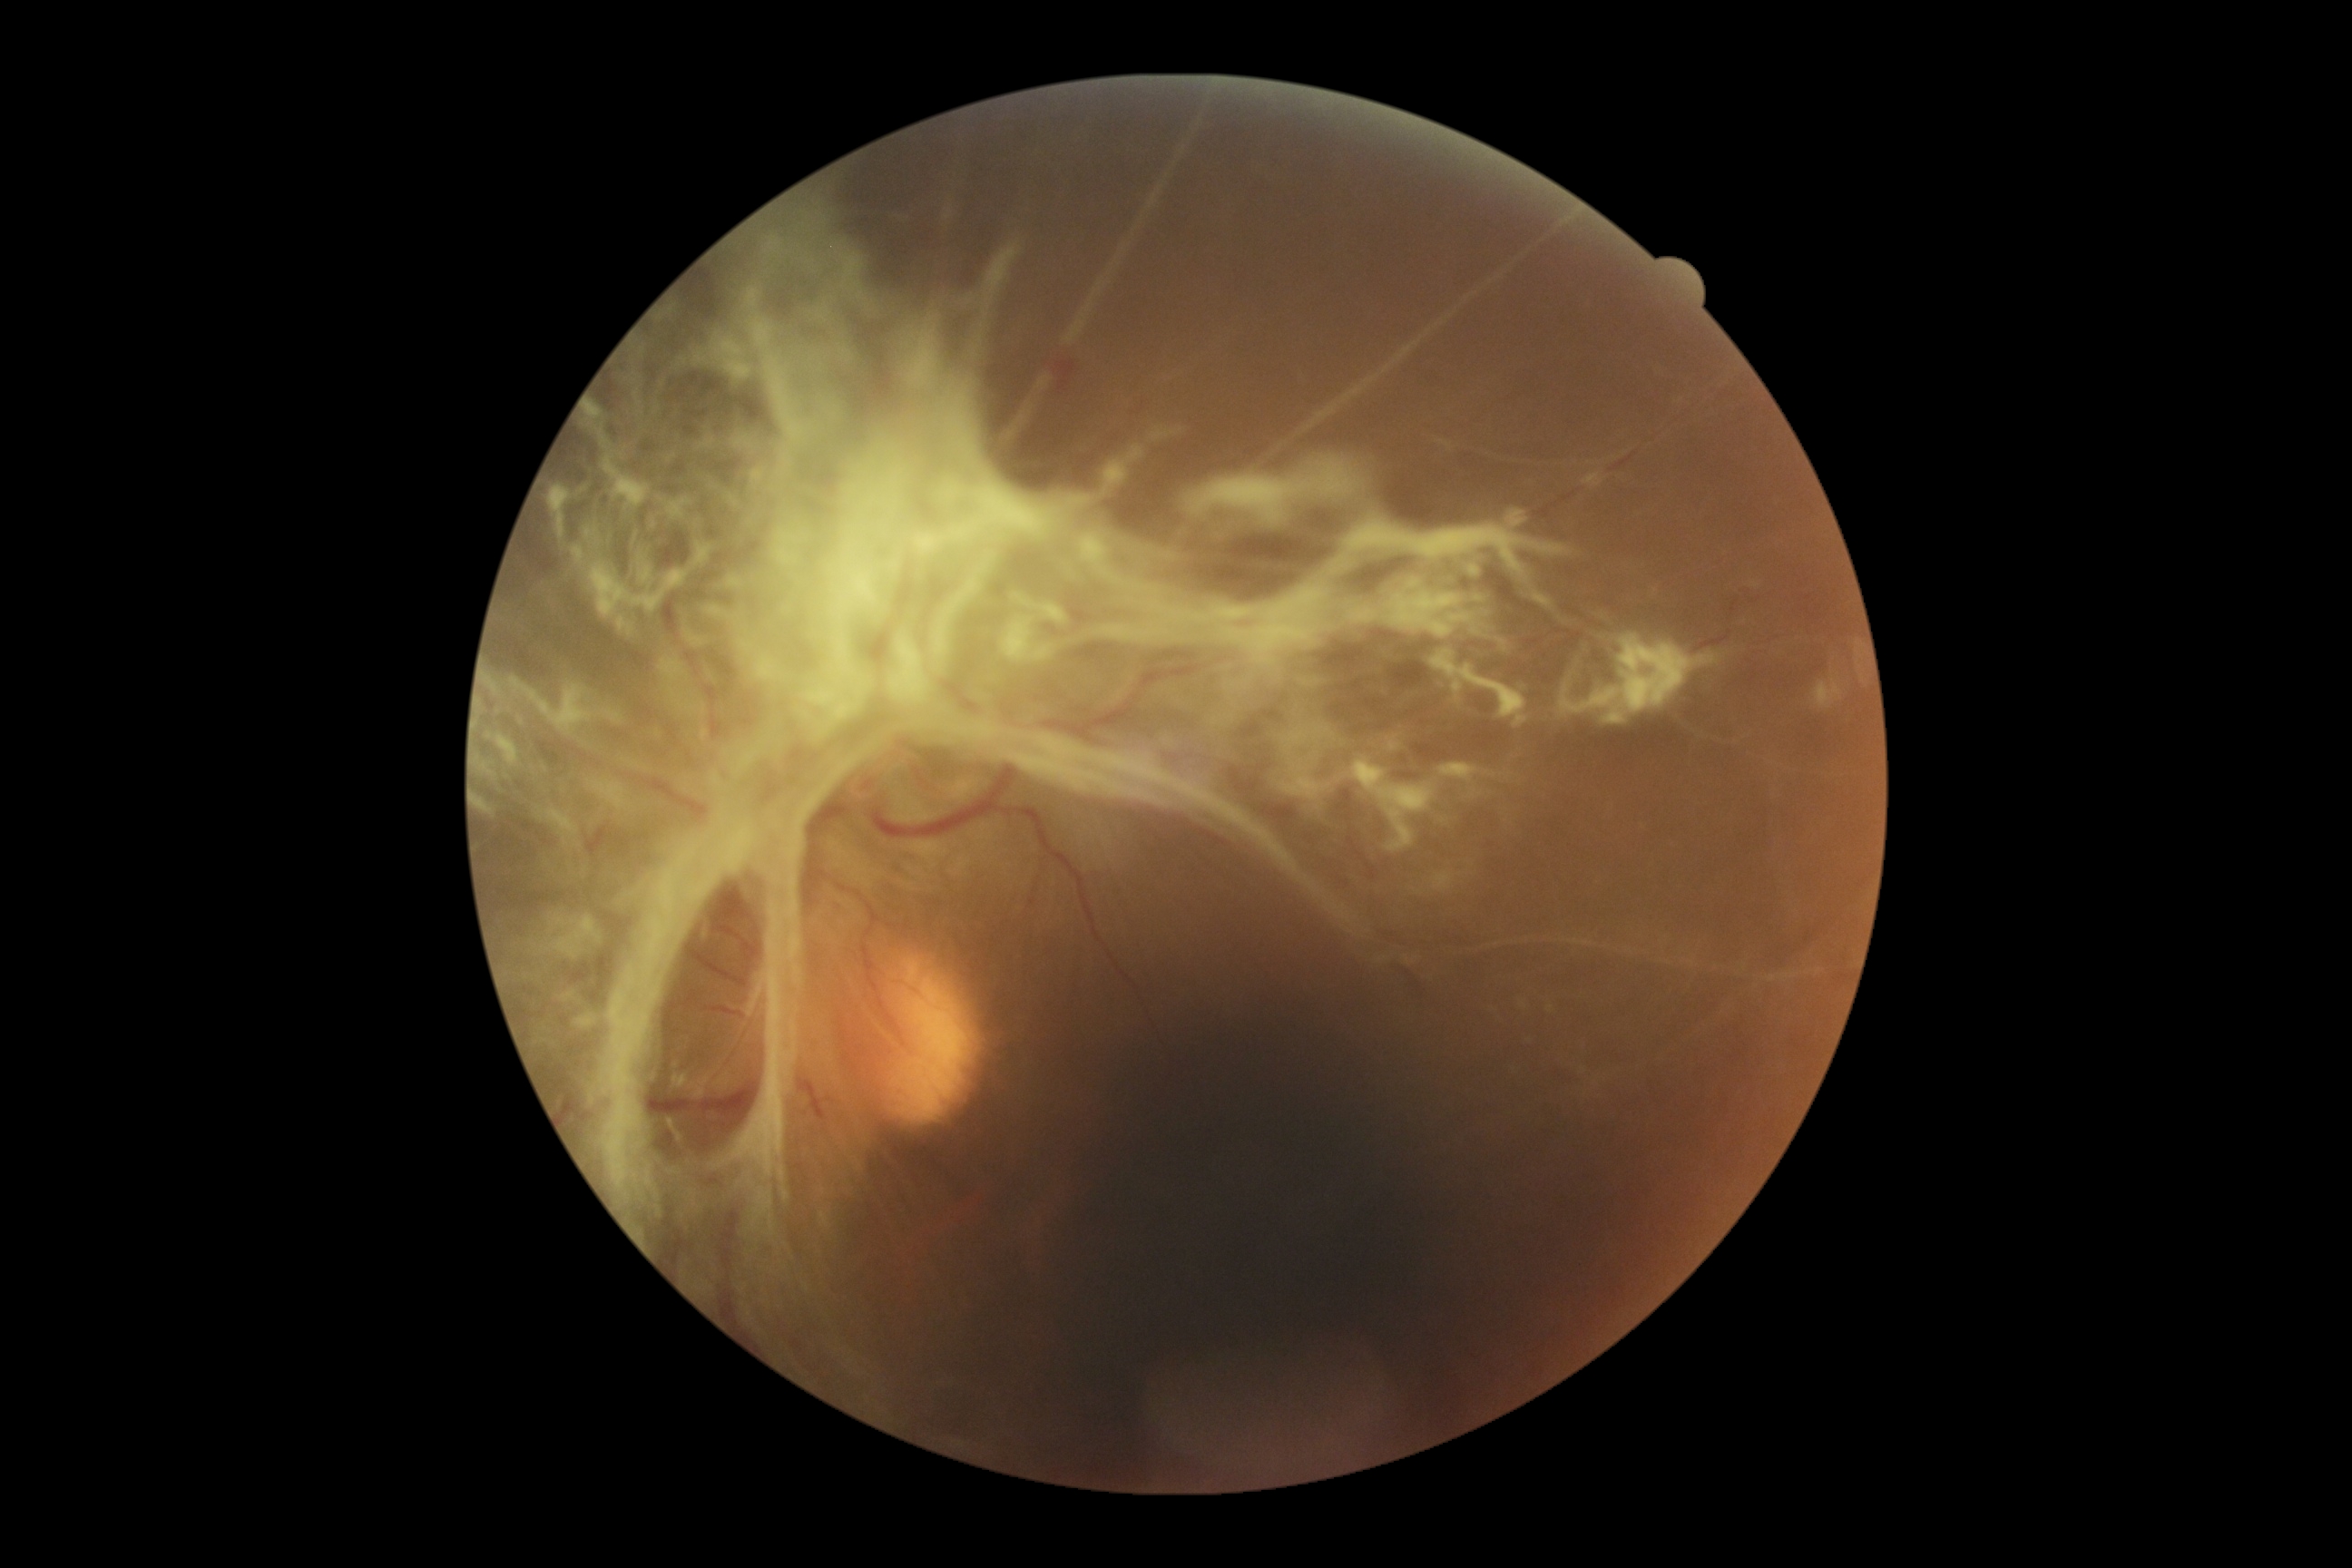

Findings:
* DR class — proliferative diabetic retinopathy
* diabetic retinopathy — 4